Pediatric wide-field fundus photograph — 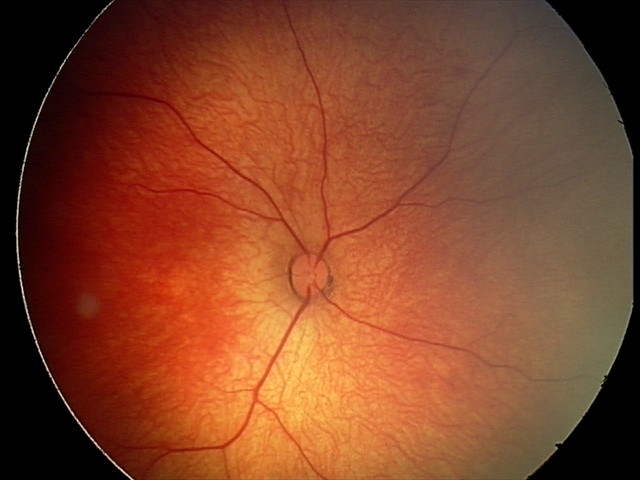 Examination diagnosed as retinal hemorrhages.